Pediatric retinal photograph (wide-field).
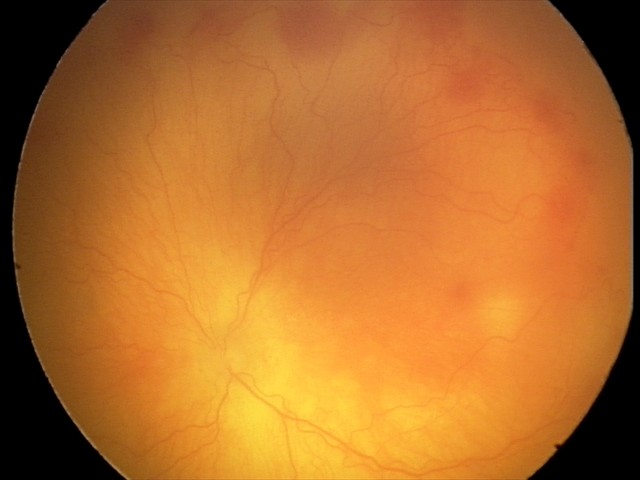
Plus disease present. From an examination with diagnosis of aggressive retinopathy of prematurity.